45° FOV · no pharmacologic dilation — 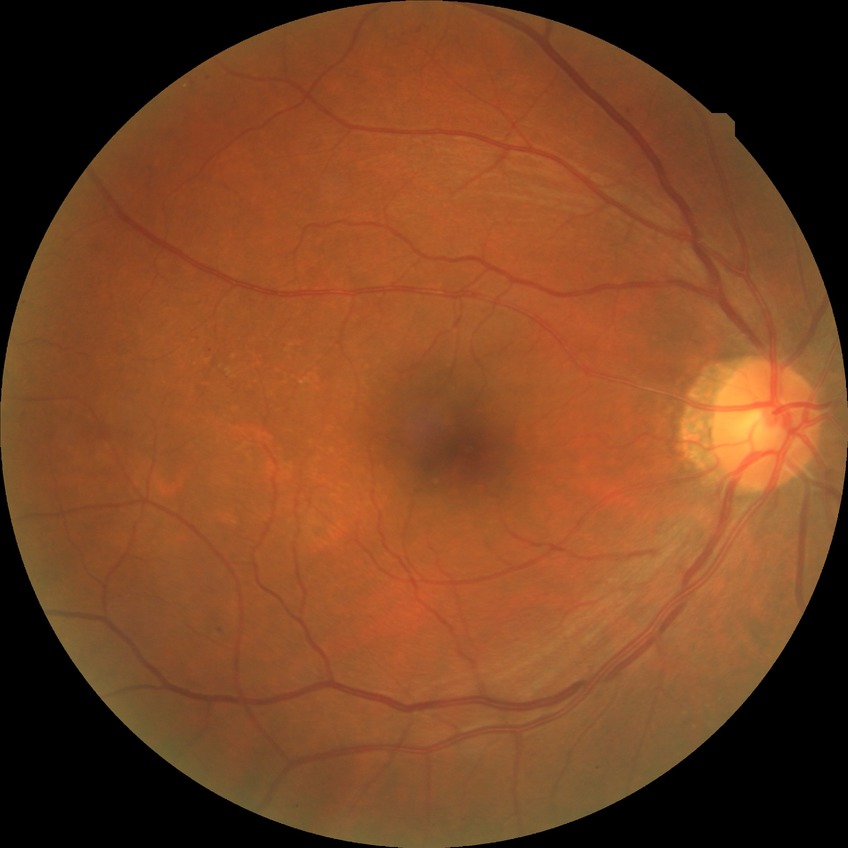
The retinopathy is classified as non-proliferative diabetic retinopathy.
Diabetic retinopathy (DR) is SDR (simple diabetic retinopathy).